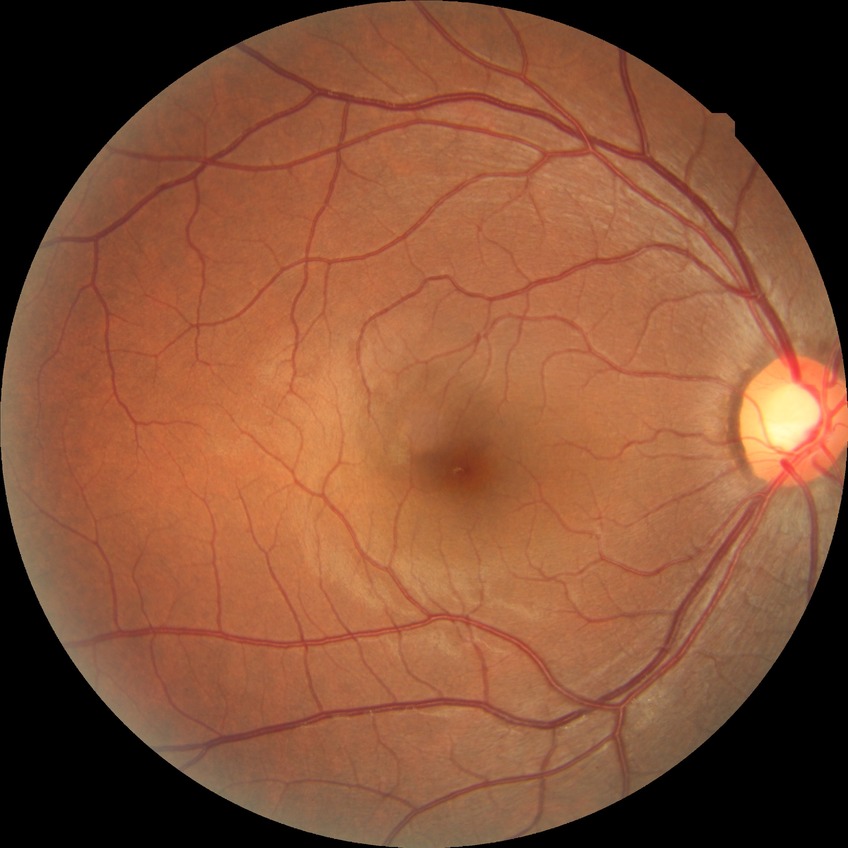 Diabetic retinopathy (DR) is no diabetic retinopathy (NDR).